RetCam wide-field infant fundus image. 640 by 480 pixels
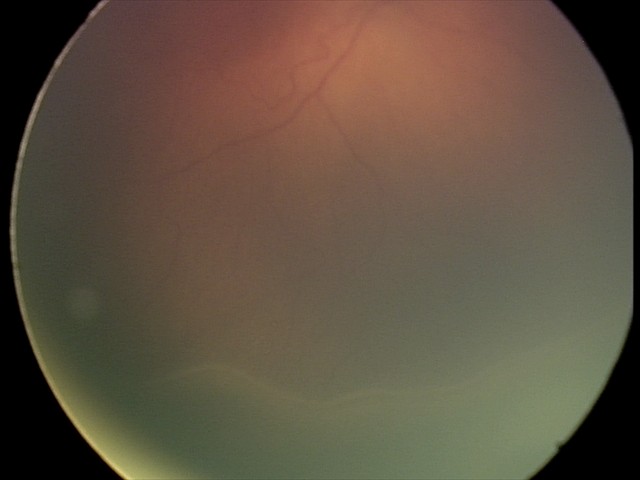

Series diagnosed as retinopathy of prematurity (ROP) stage 2 — ridge with height and width at the demarcation line. Without plus disease.